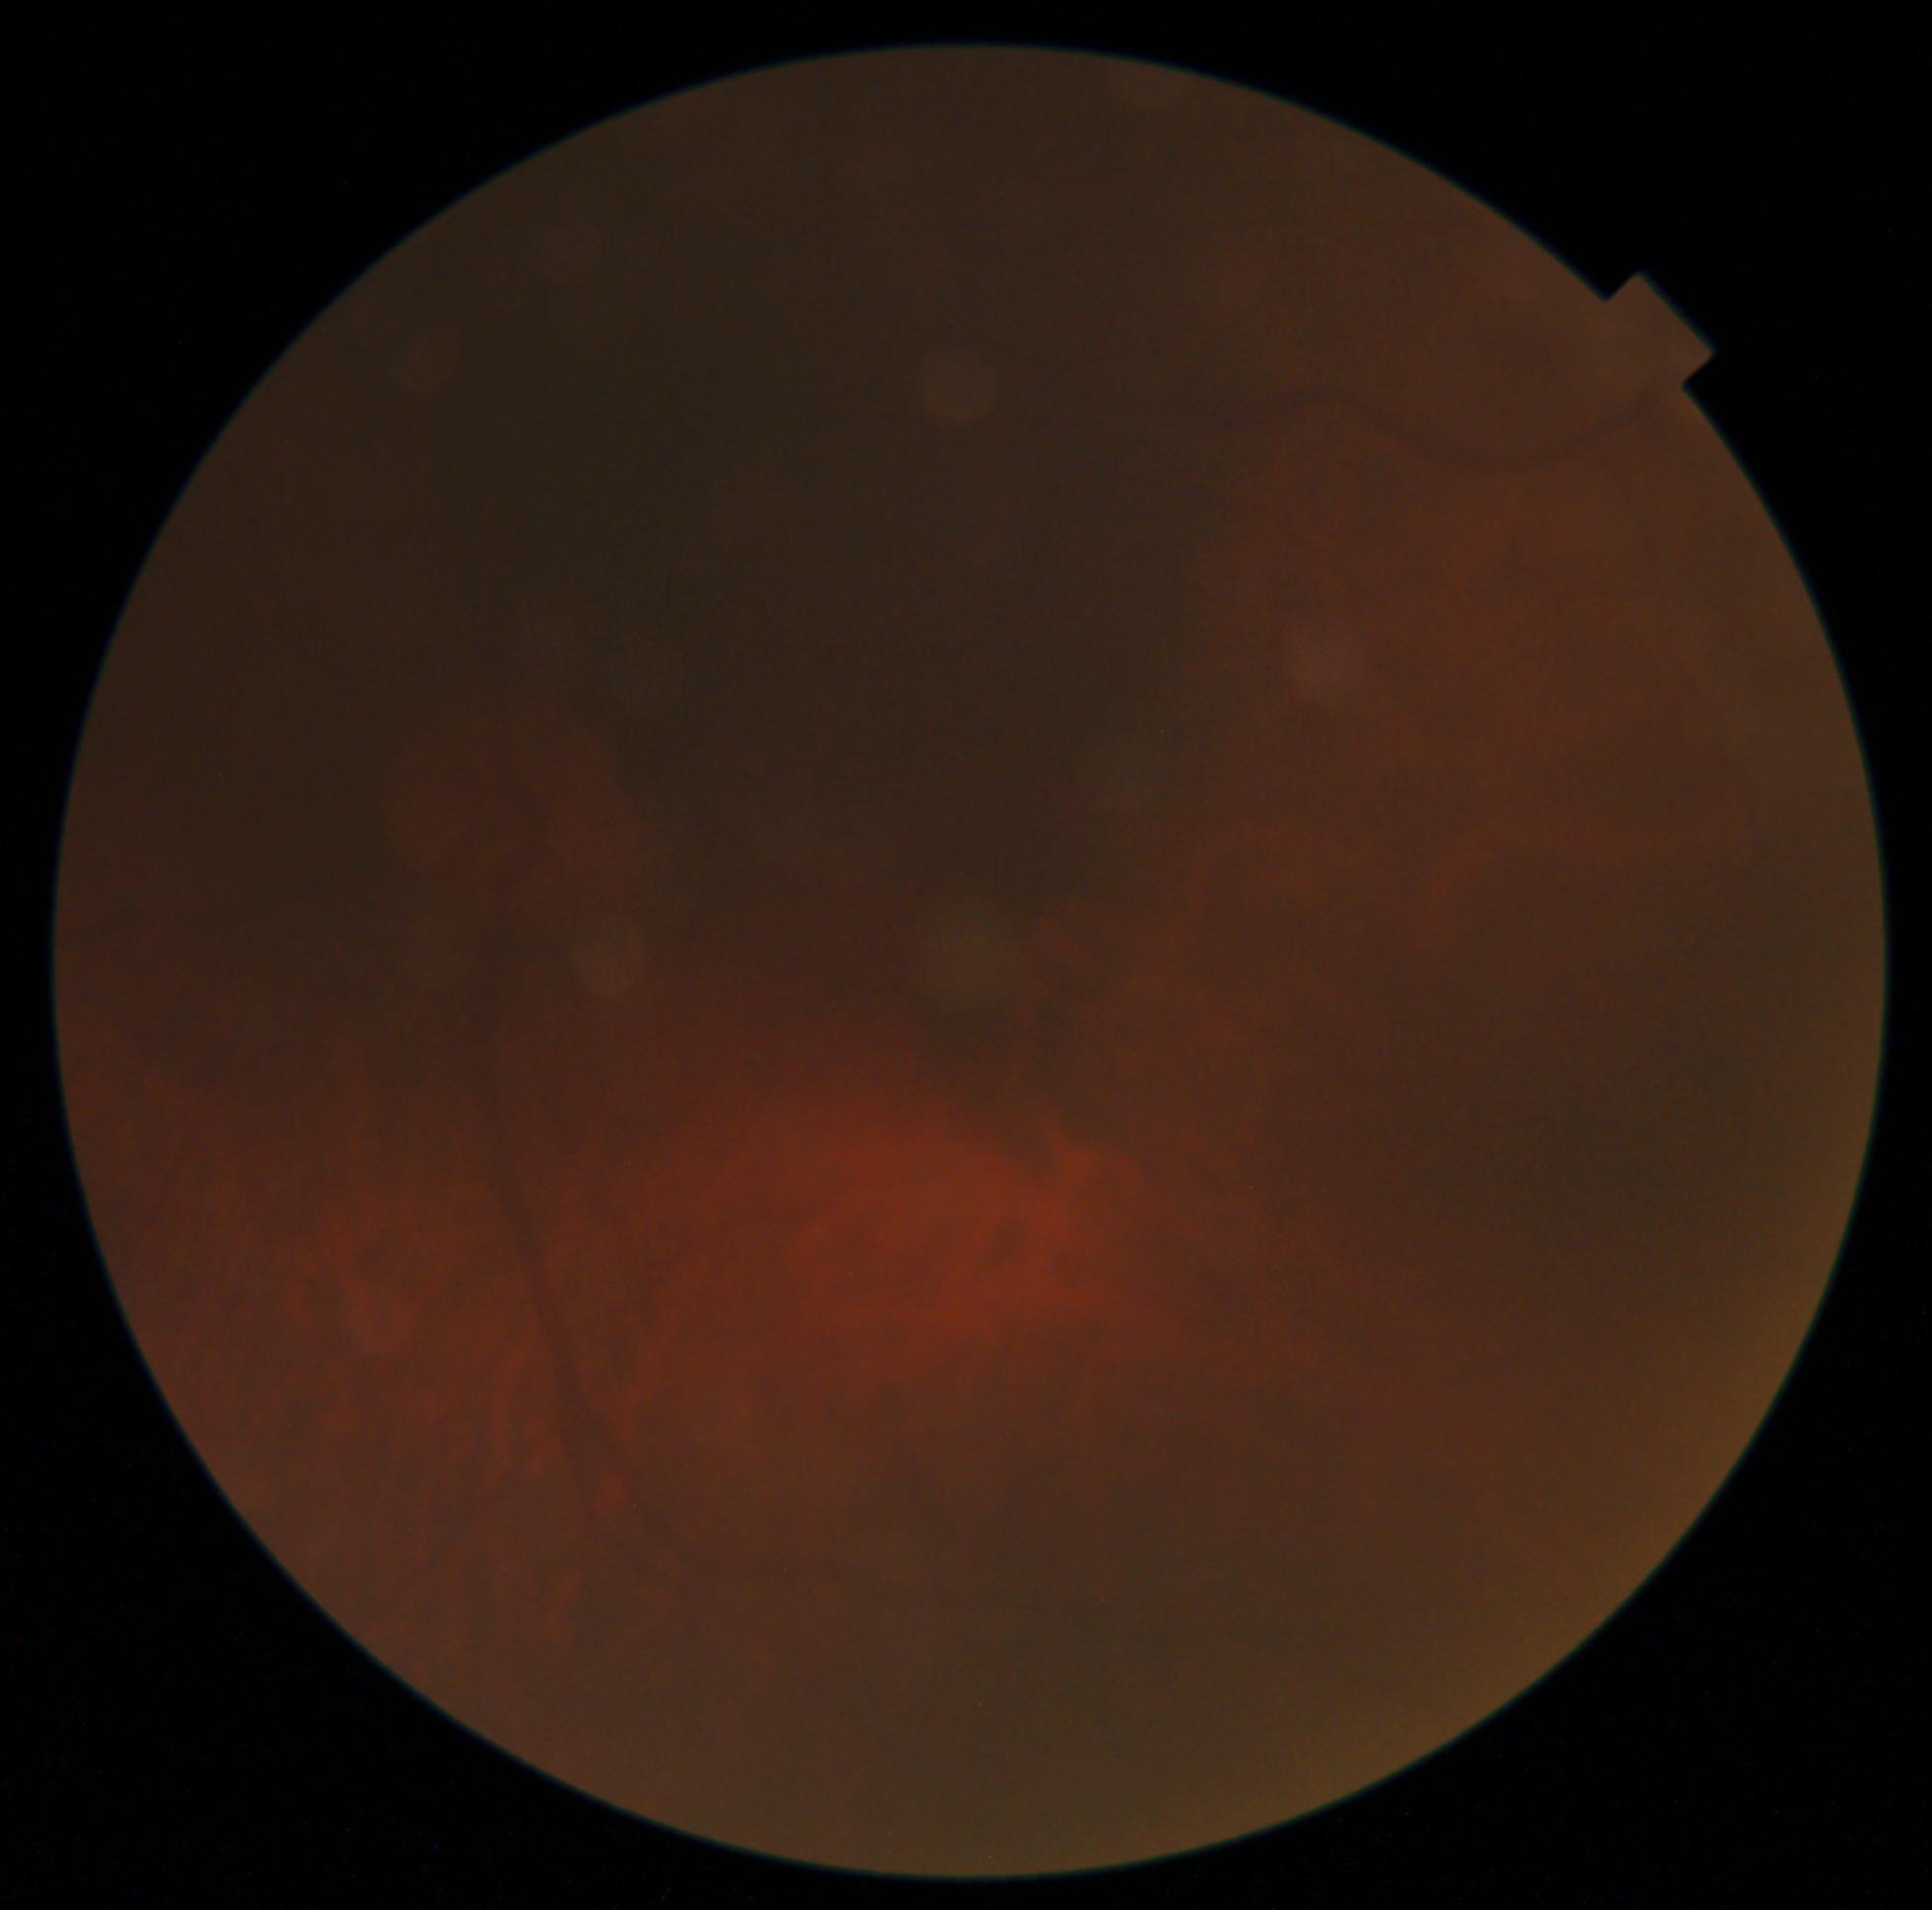

Diabetic retinopathy (DR) is ungradable.